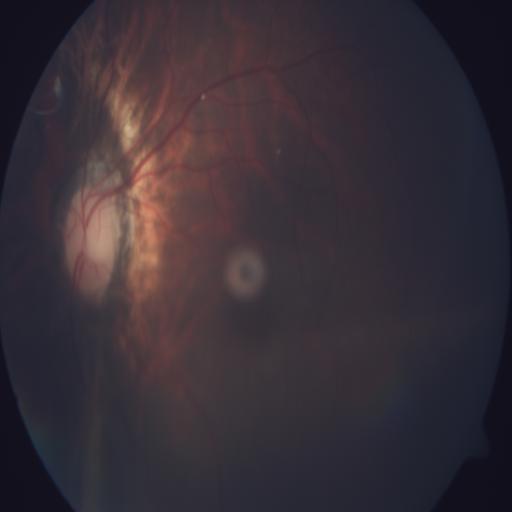

Diagnoses (4):
- MH (media haze)
- MYA (myopia)
- ODC (optic disc cupping)
- TSLN (tessellation)